Wide-field contact fundus photograph of an infant
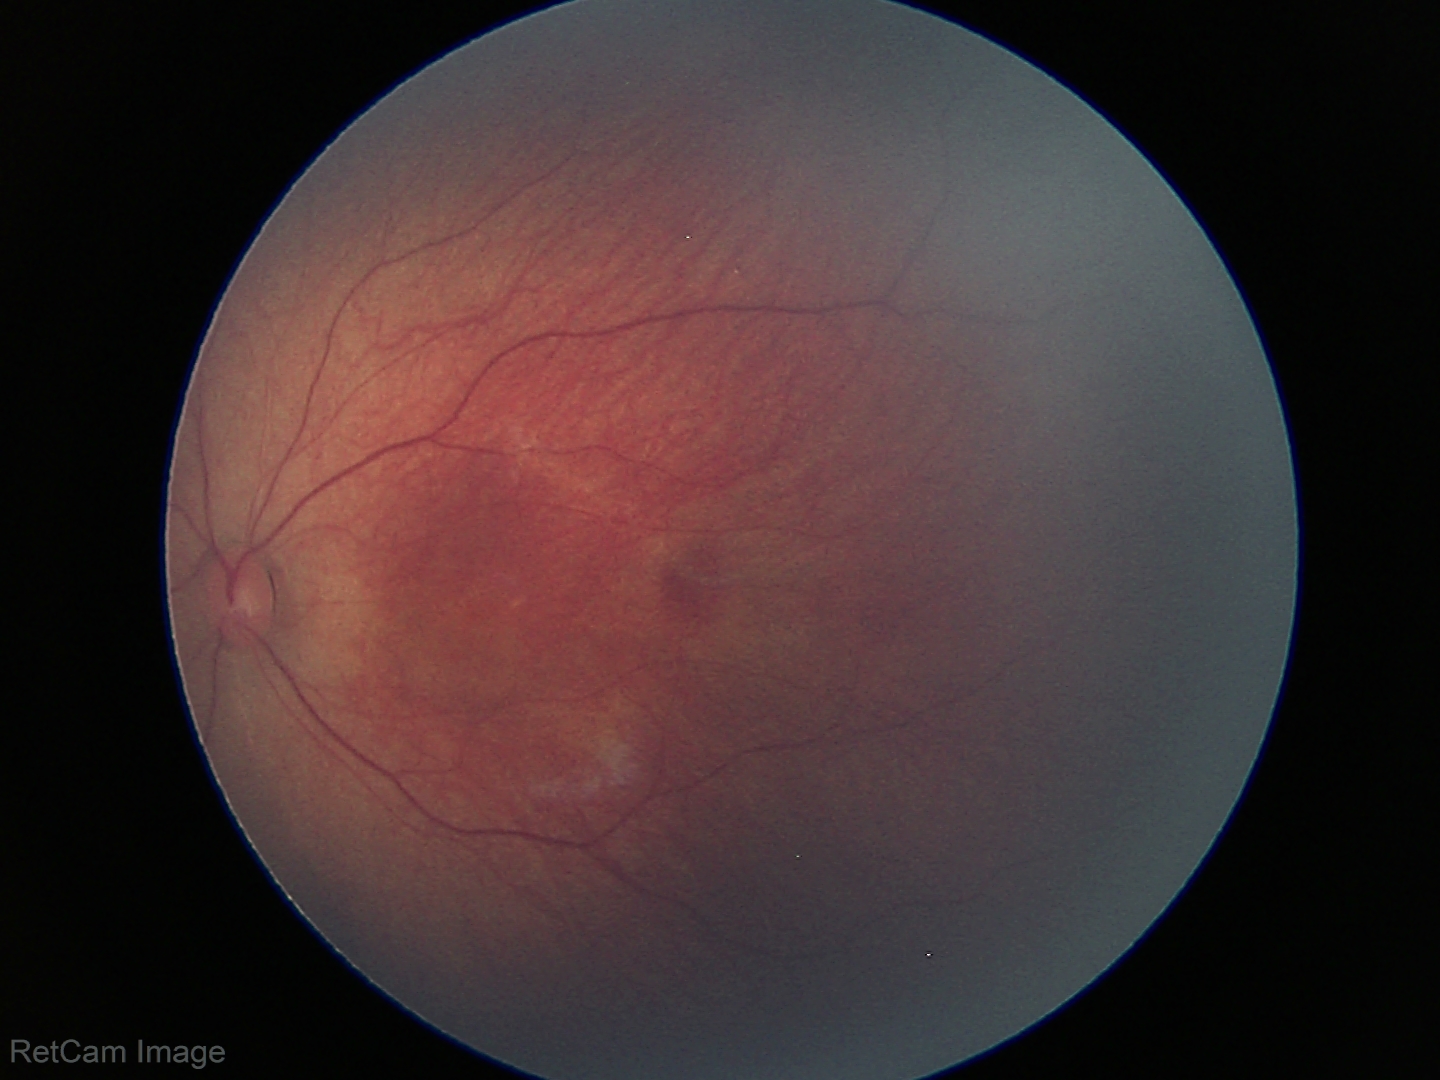

Diagnosis = normal retinal appearance.